45° FOV. 2352 by 1568 pixels. Fundus photo
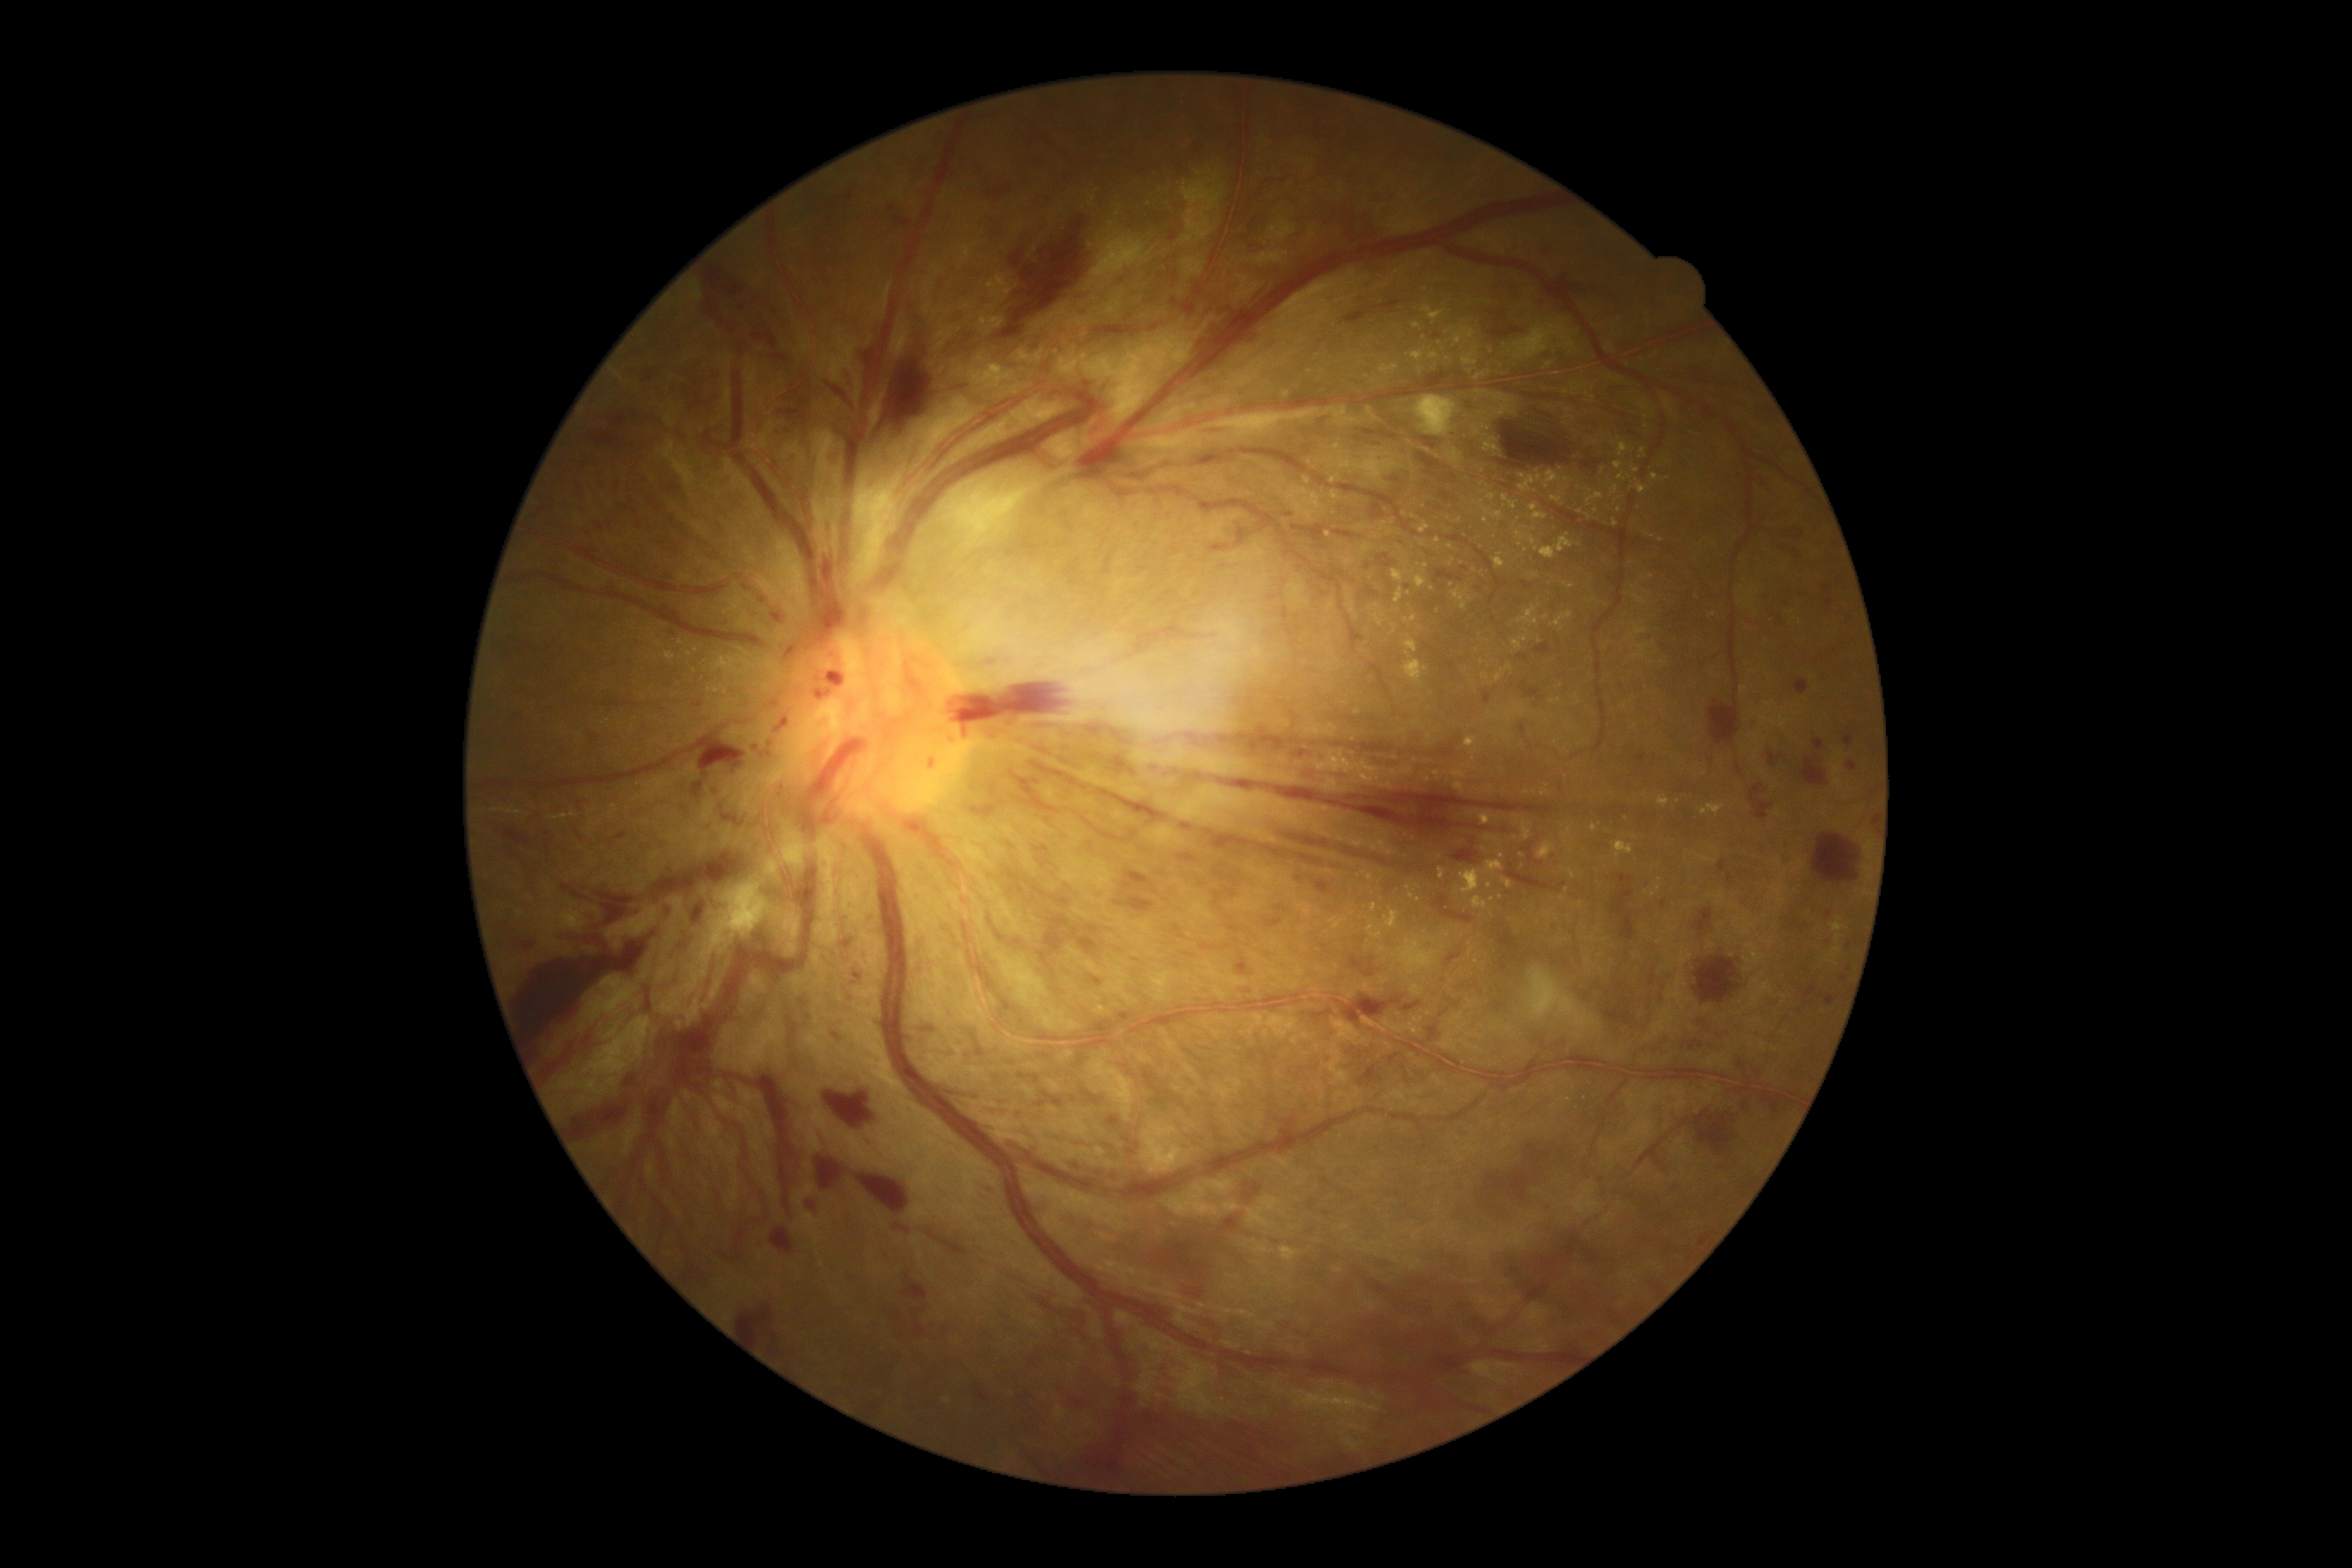

DR stage: grade 4. HEs include BBox(1620, 917, 1636, 941); BBox(1106, 1117, 1122, 1127); BBox(1012, 773, 1062, 814); BBox(1696, 907, 1713, 934); BBox(1199, 728, 1466, 761); BBox(1184, 953, 1192, 959); BBox(1847, 763, 1858, 771); BBox(1020, 178, 1027, 188); BBox(611, 833, 628, 845); BBox(976, 1046, 984, 1058); BBox(1708, 701, 1739, 745); BBox(984, 171, 996, 187); BBox(1700, 1237, 1708, 1244); BBox(1124, 871, 1158, 895); BBox(1292, 525, 1326, 542); BBox(1177, 855, 1196, 862); BBox(946, 314, 967, 326); BBox(1383, 298, 1404, 312). Small HEs near 1408, 871. EXs include BBox(1421, 305, 1445, 324); BBox(1638, 486, 1648, 496); BBox(707, 689, 720, 694); BBox(1634, 596, 1648, 606); BBox(1574, 902, 1583, 909); BBox(1514, 635, 1528, 651); BBox(1701, 804, 1725, 816); BBox(1440, 867, 1447, 879); BBox(1411, 350, 1424, 362). Small EXs near 726, 691; 727, 661; 1485, 676; 1364, 872; 981, 321; 1484, 850; 1635, 588; 1658, 888; 1618, 466; 1489, 887.